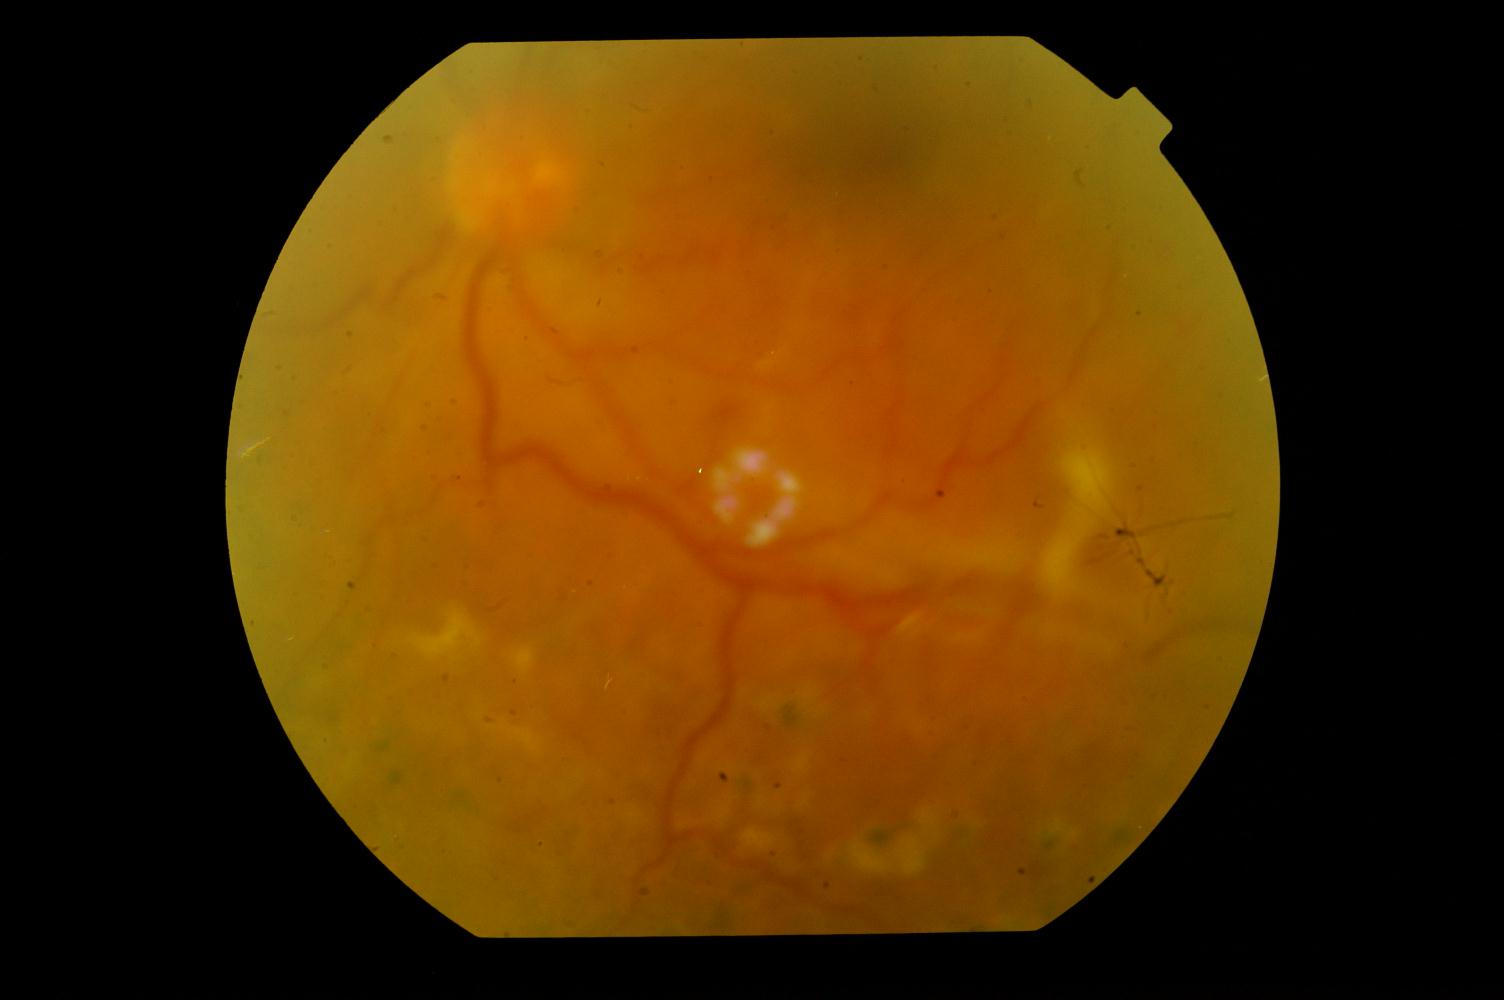 Demonstrates diabetic retinopathy.